Modified Davis grading
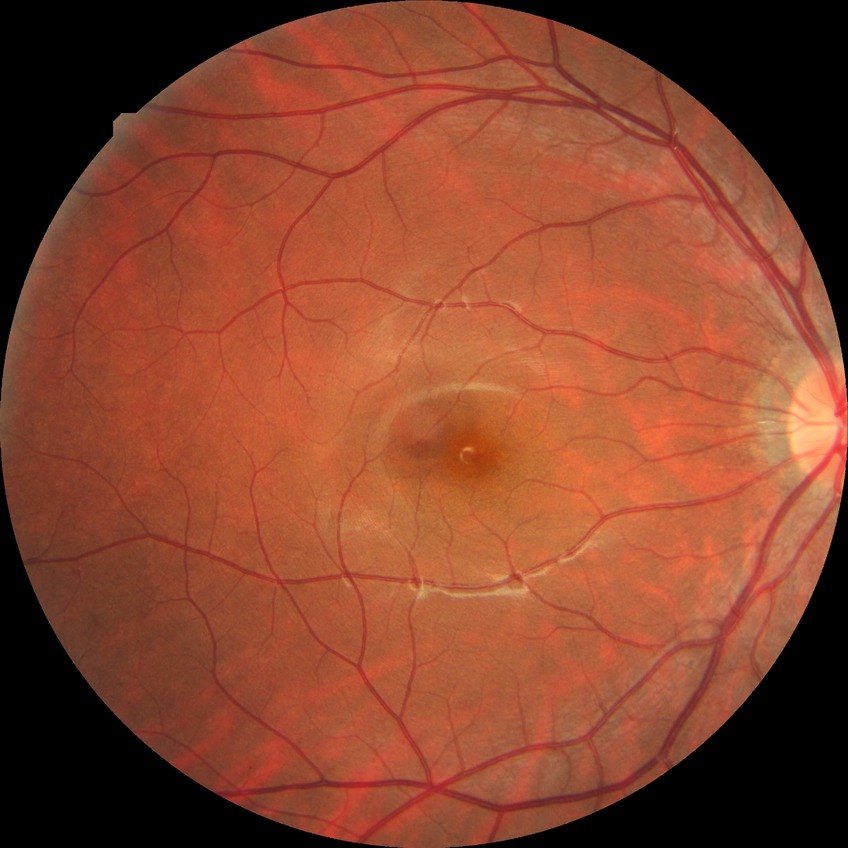
Diabetic retinopathy (DR): NDR (no diabetic retinopathy).